2346 x 1568 pixels — 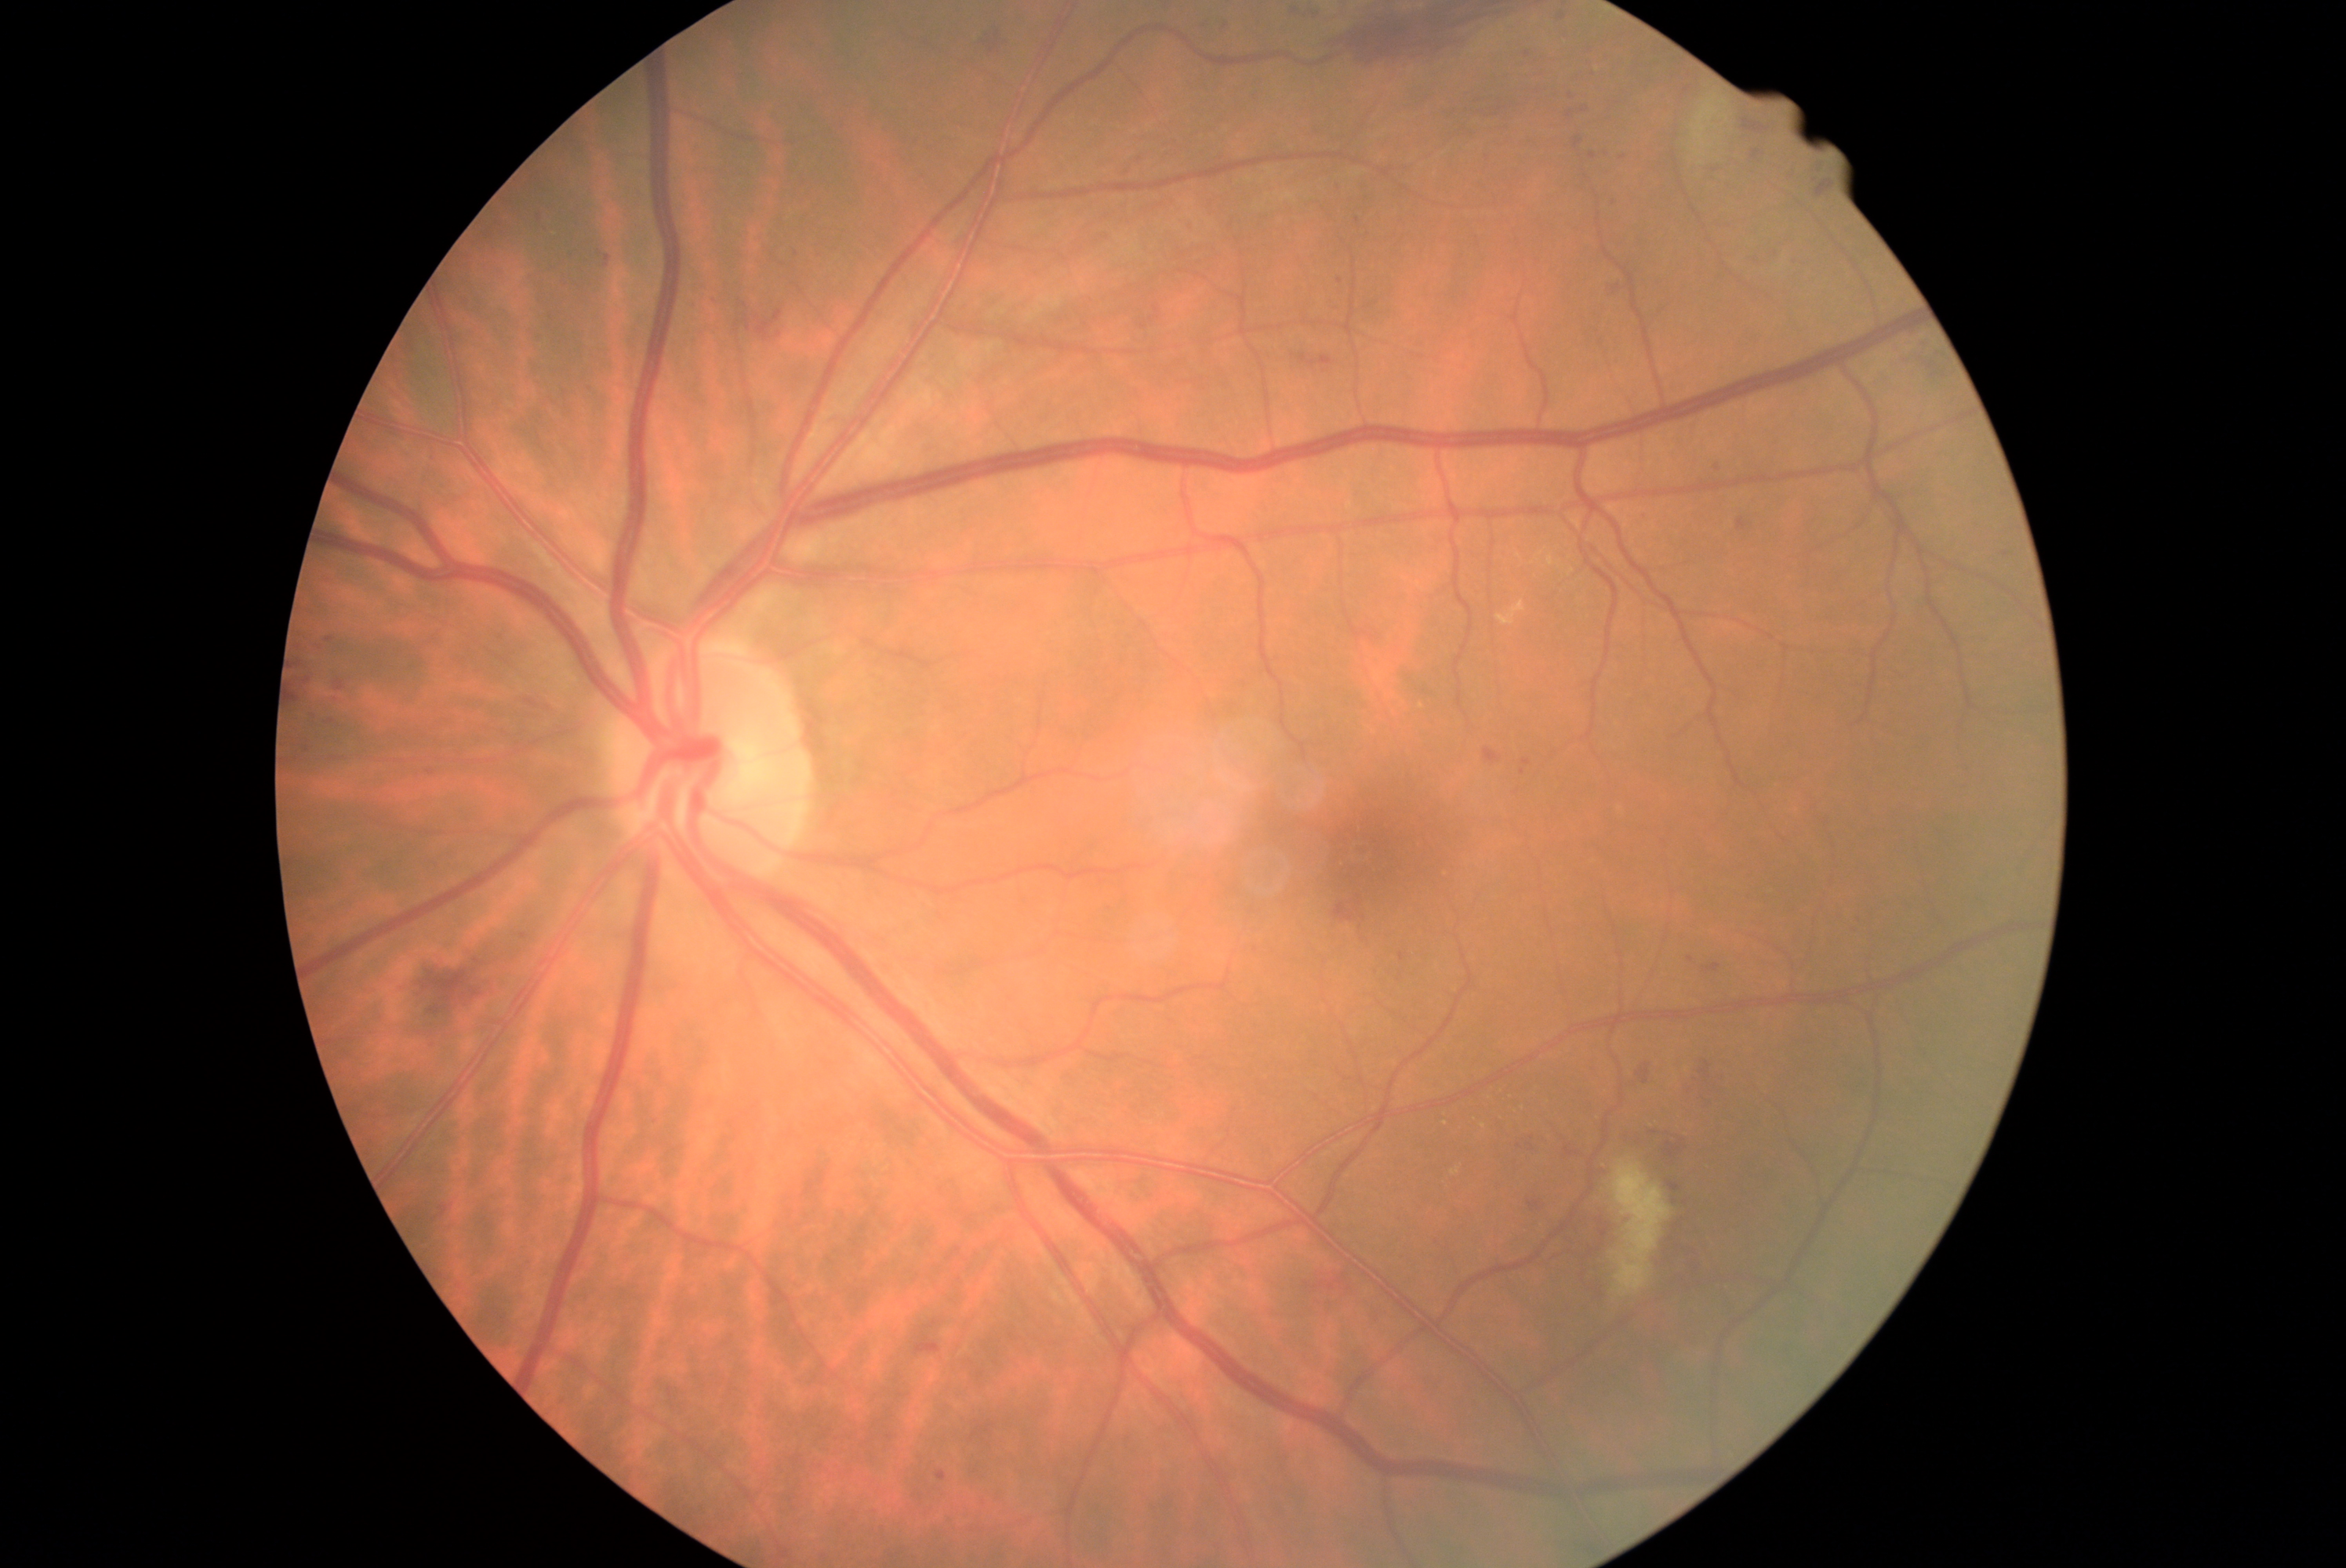

<lesions partial="true">
  <dr_grade>2</dr_grade>
  <ma partial="true">1603 151 1611 159; 1669 1185 1680 1192; 1306 9 1316 18; 1704 964 1721 975; 336 681 346 692; 1674 1202 1679 1211; 1400 953 1406 962; 1641 512 1651 520</ma>
  <ma_small_centers>(1340, 282); (306, 749); (1358, 222); (797, 254); (1624, 156); (1529, 55); (1585, 110)</ma_small_centers>
  <he partial="true">1528 1202 1541 1211; 1911 347 1952 379; 1699 1072 1729 1100; 1484 749 1503 766; 1520 1144 1541 1156; 1585 1268 1603 1298; 1592 1218 1607 1254; 1810 156 1828 169; 423 970 484 1015; 1117 159 1130 170; 1301 355 1335 368; 297 661 305 669; 735 316 752 333; 1335 904 1354 923</he>
</lesions>